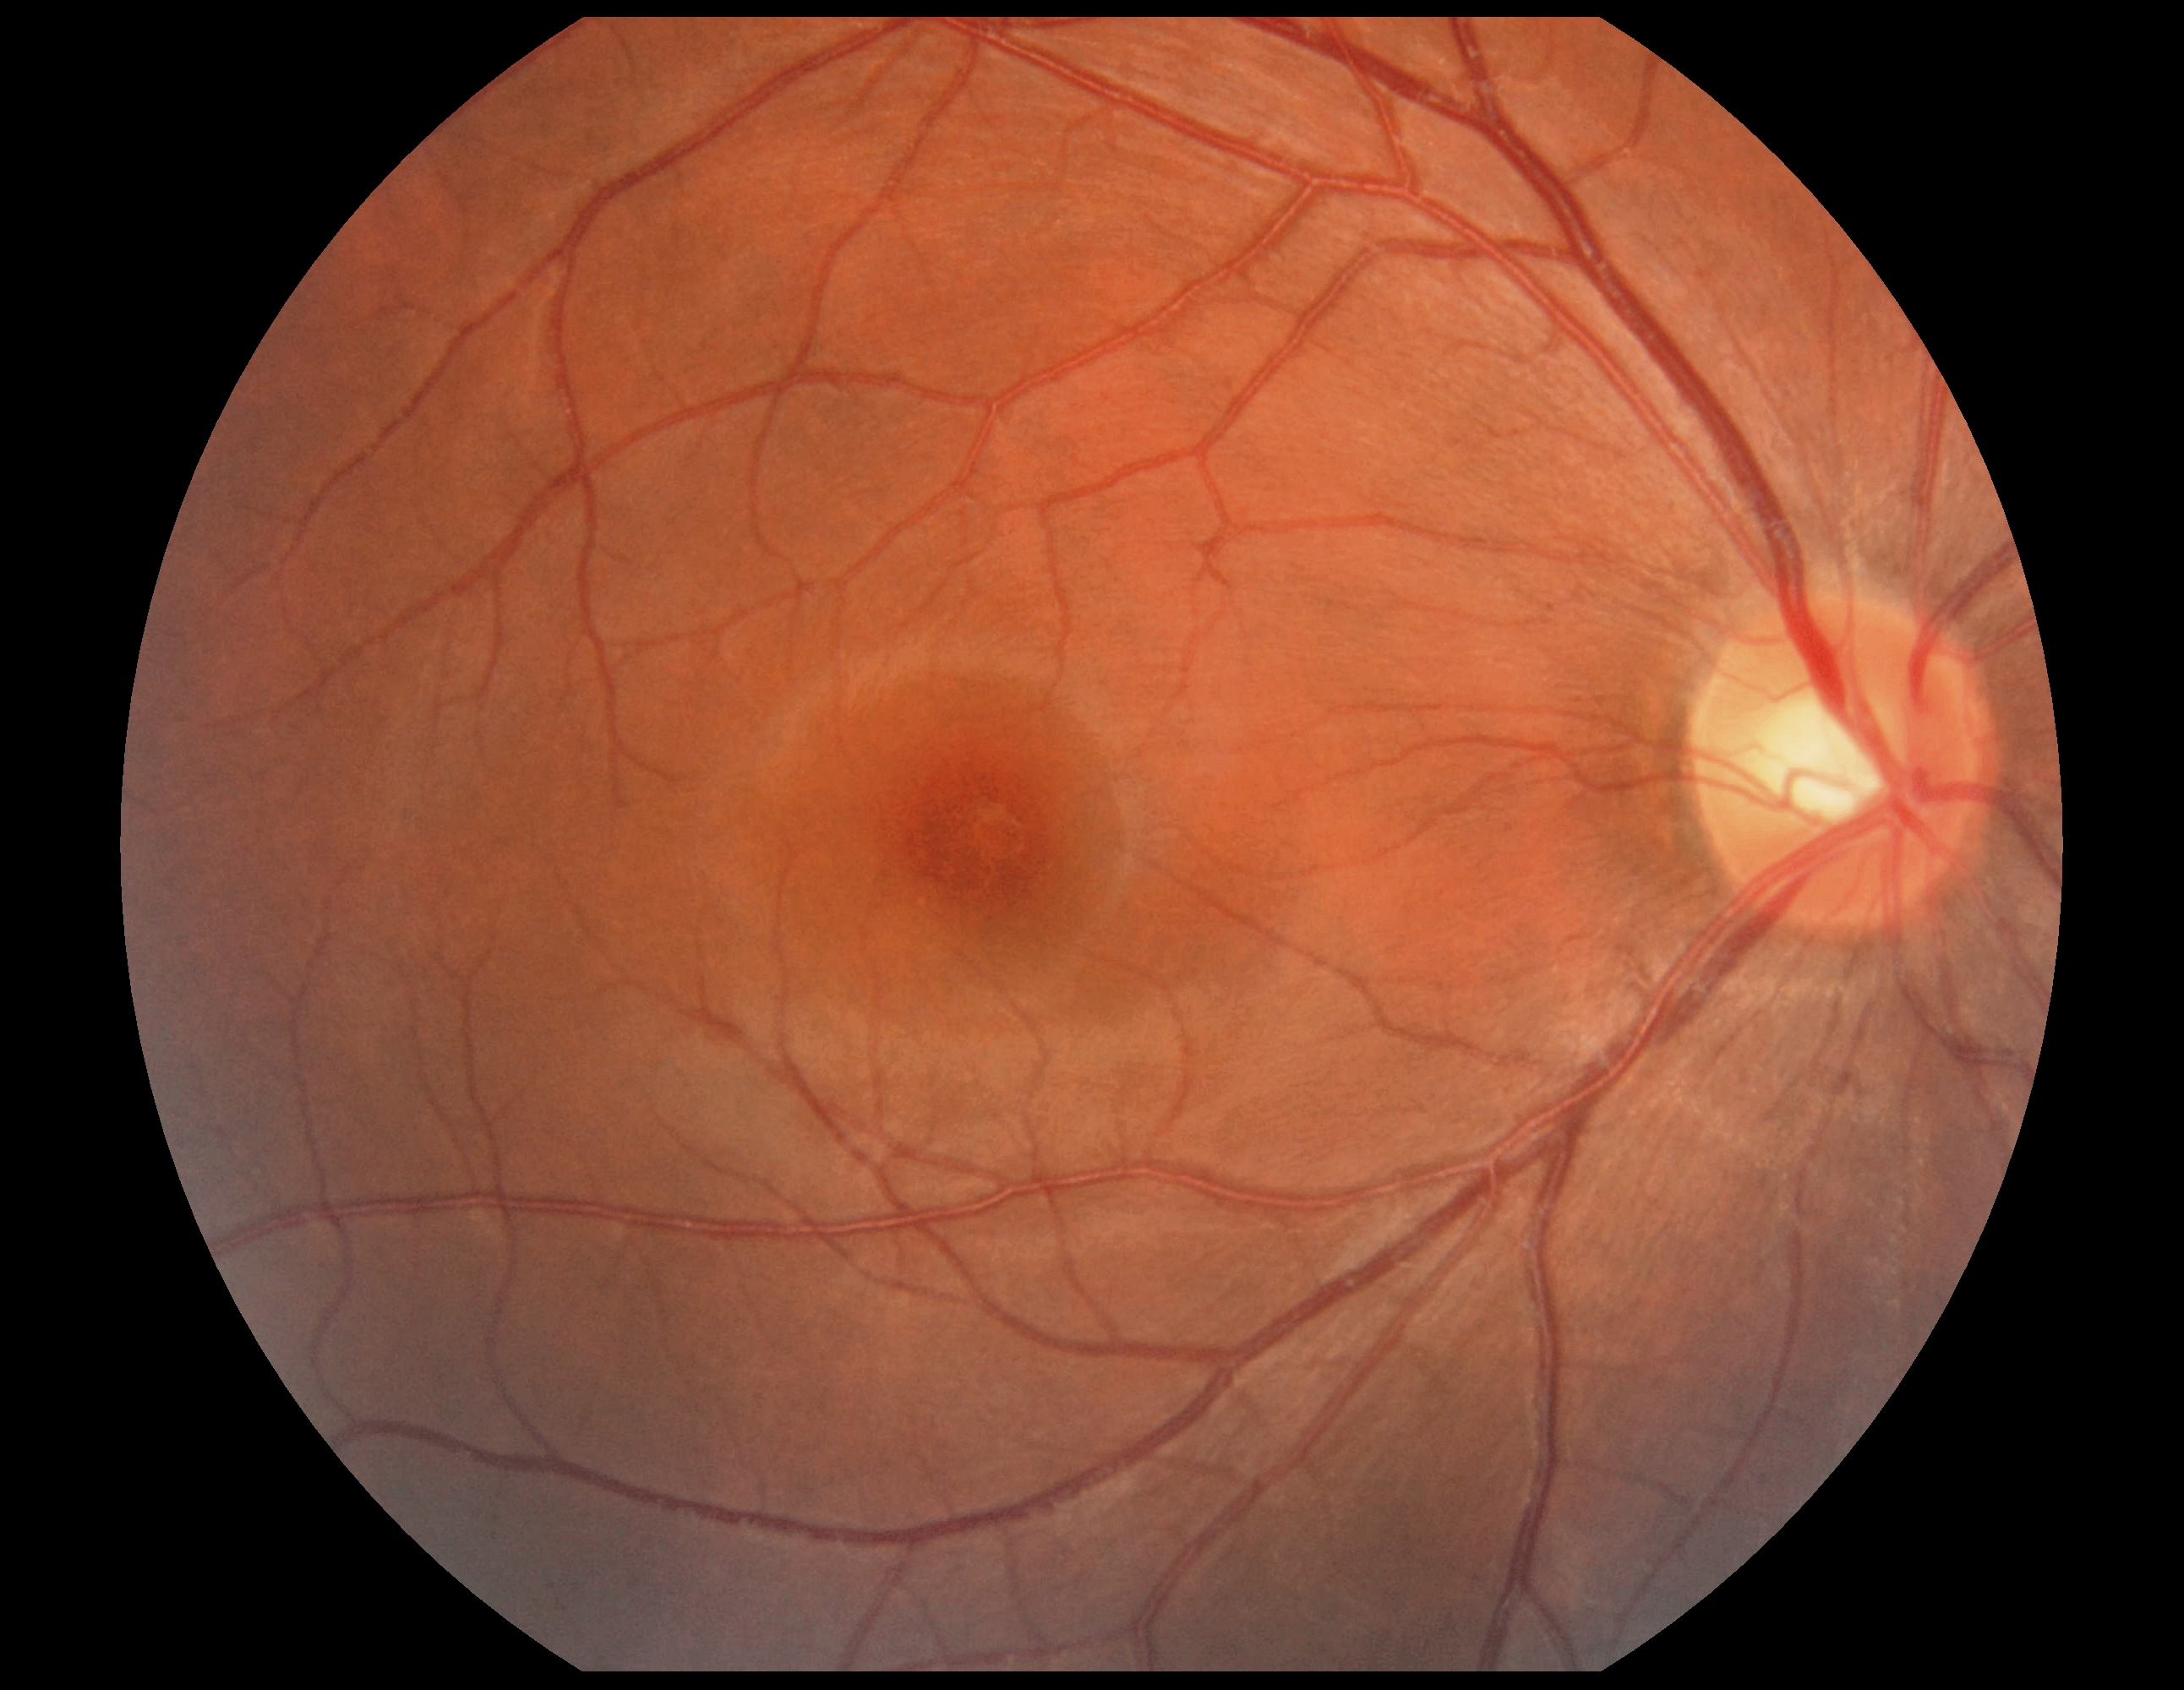

{
  "dr_grade": "grade 0"
}